Wide-field fundus image from infant ROP screening — 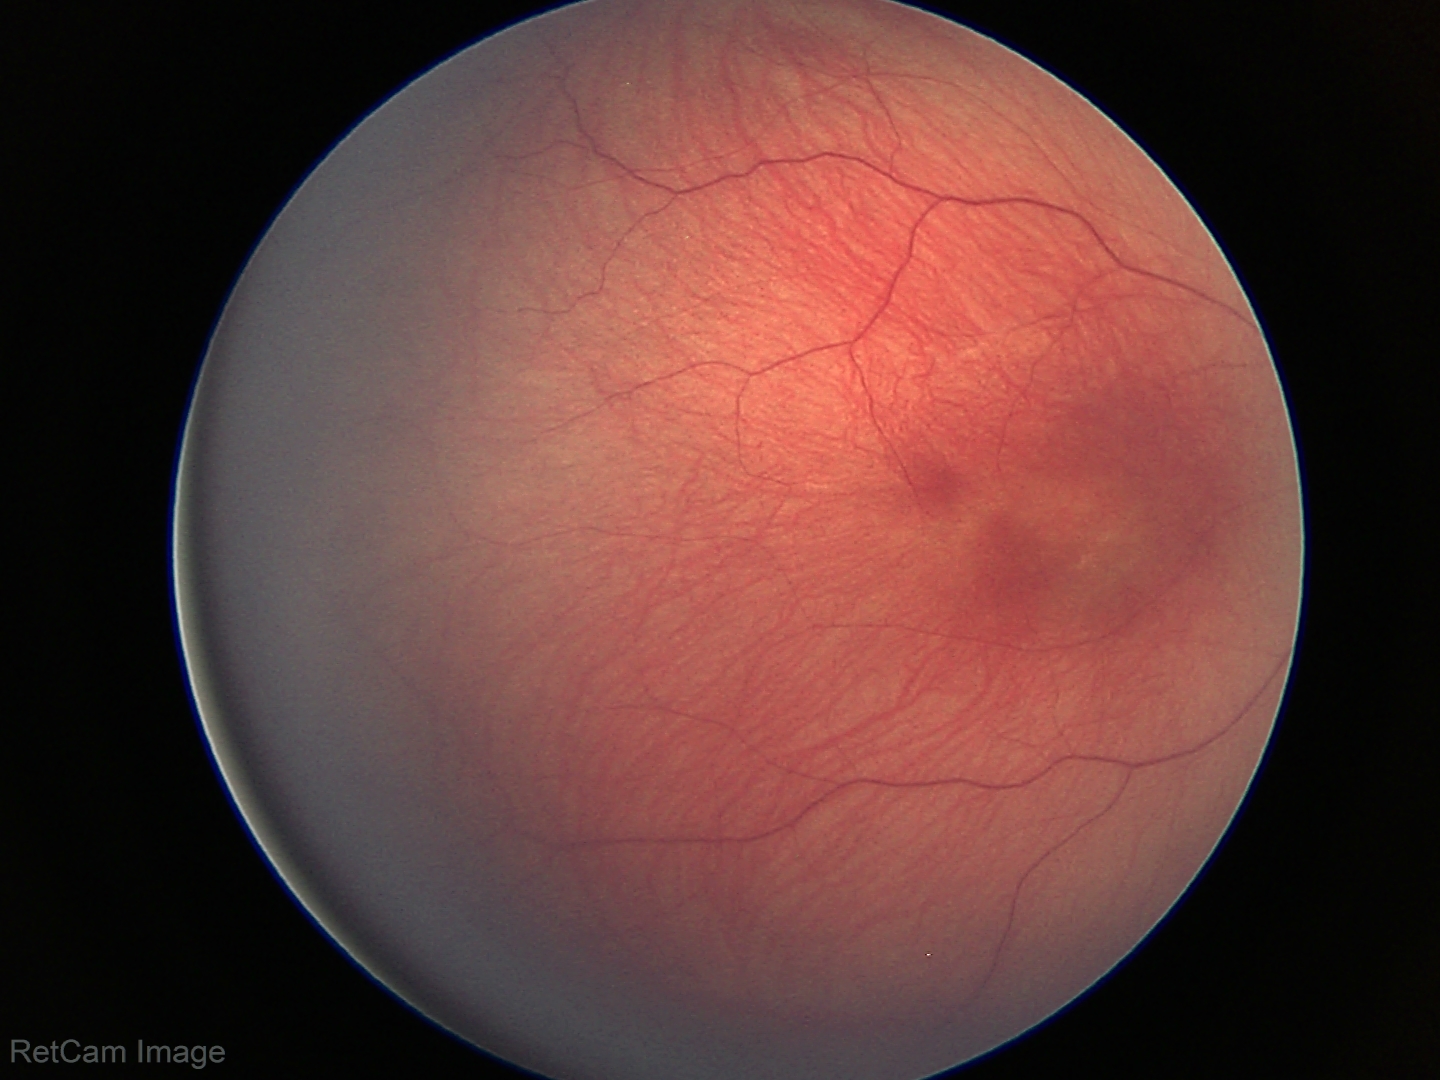 Q: What is the screening diagnosis?
A: status post retinopathy of prematurity (ROP)
Q: Plus disease status?
A: no plus disease